RetCam wide-field infant fundus image. Camera: Clarity RetCam 3 (130° FOV). 640 x 480 pixels
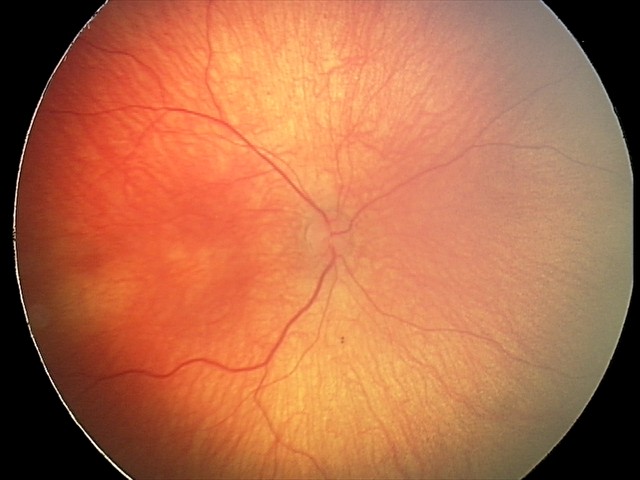

Q: What is the screening diagnosis?
A: physiological appearance with no retinal pathology